45° FOV.
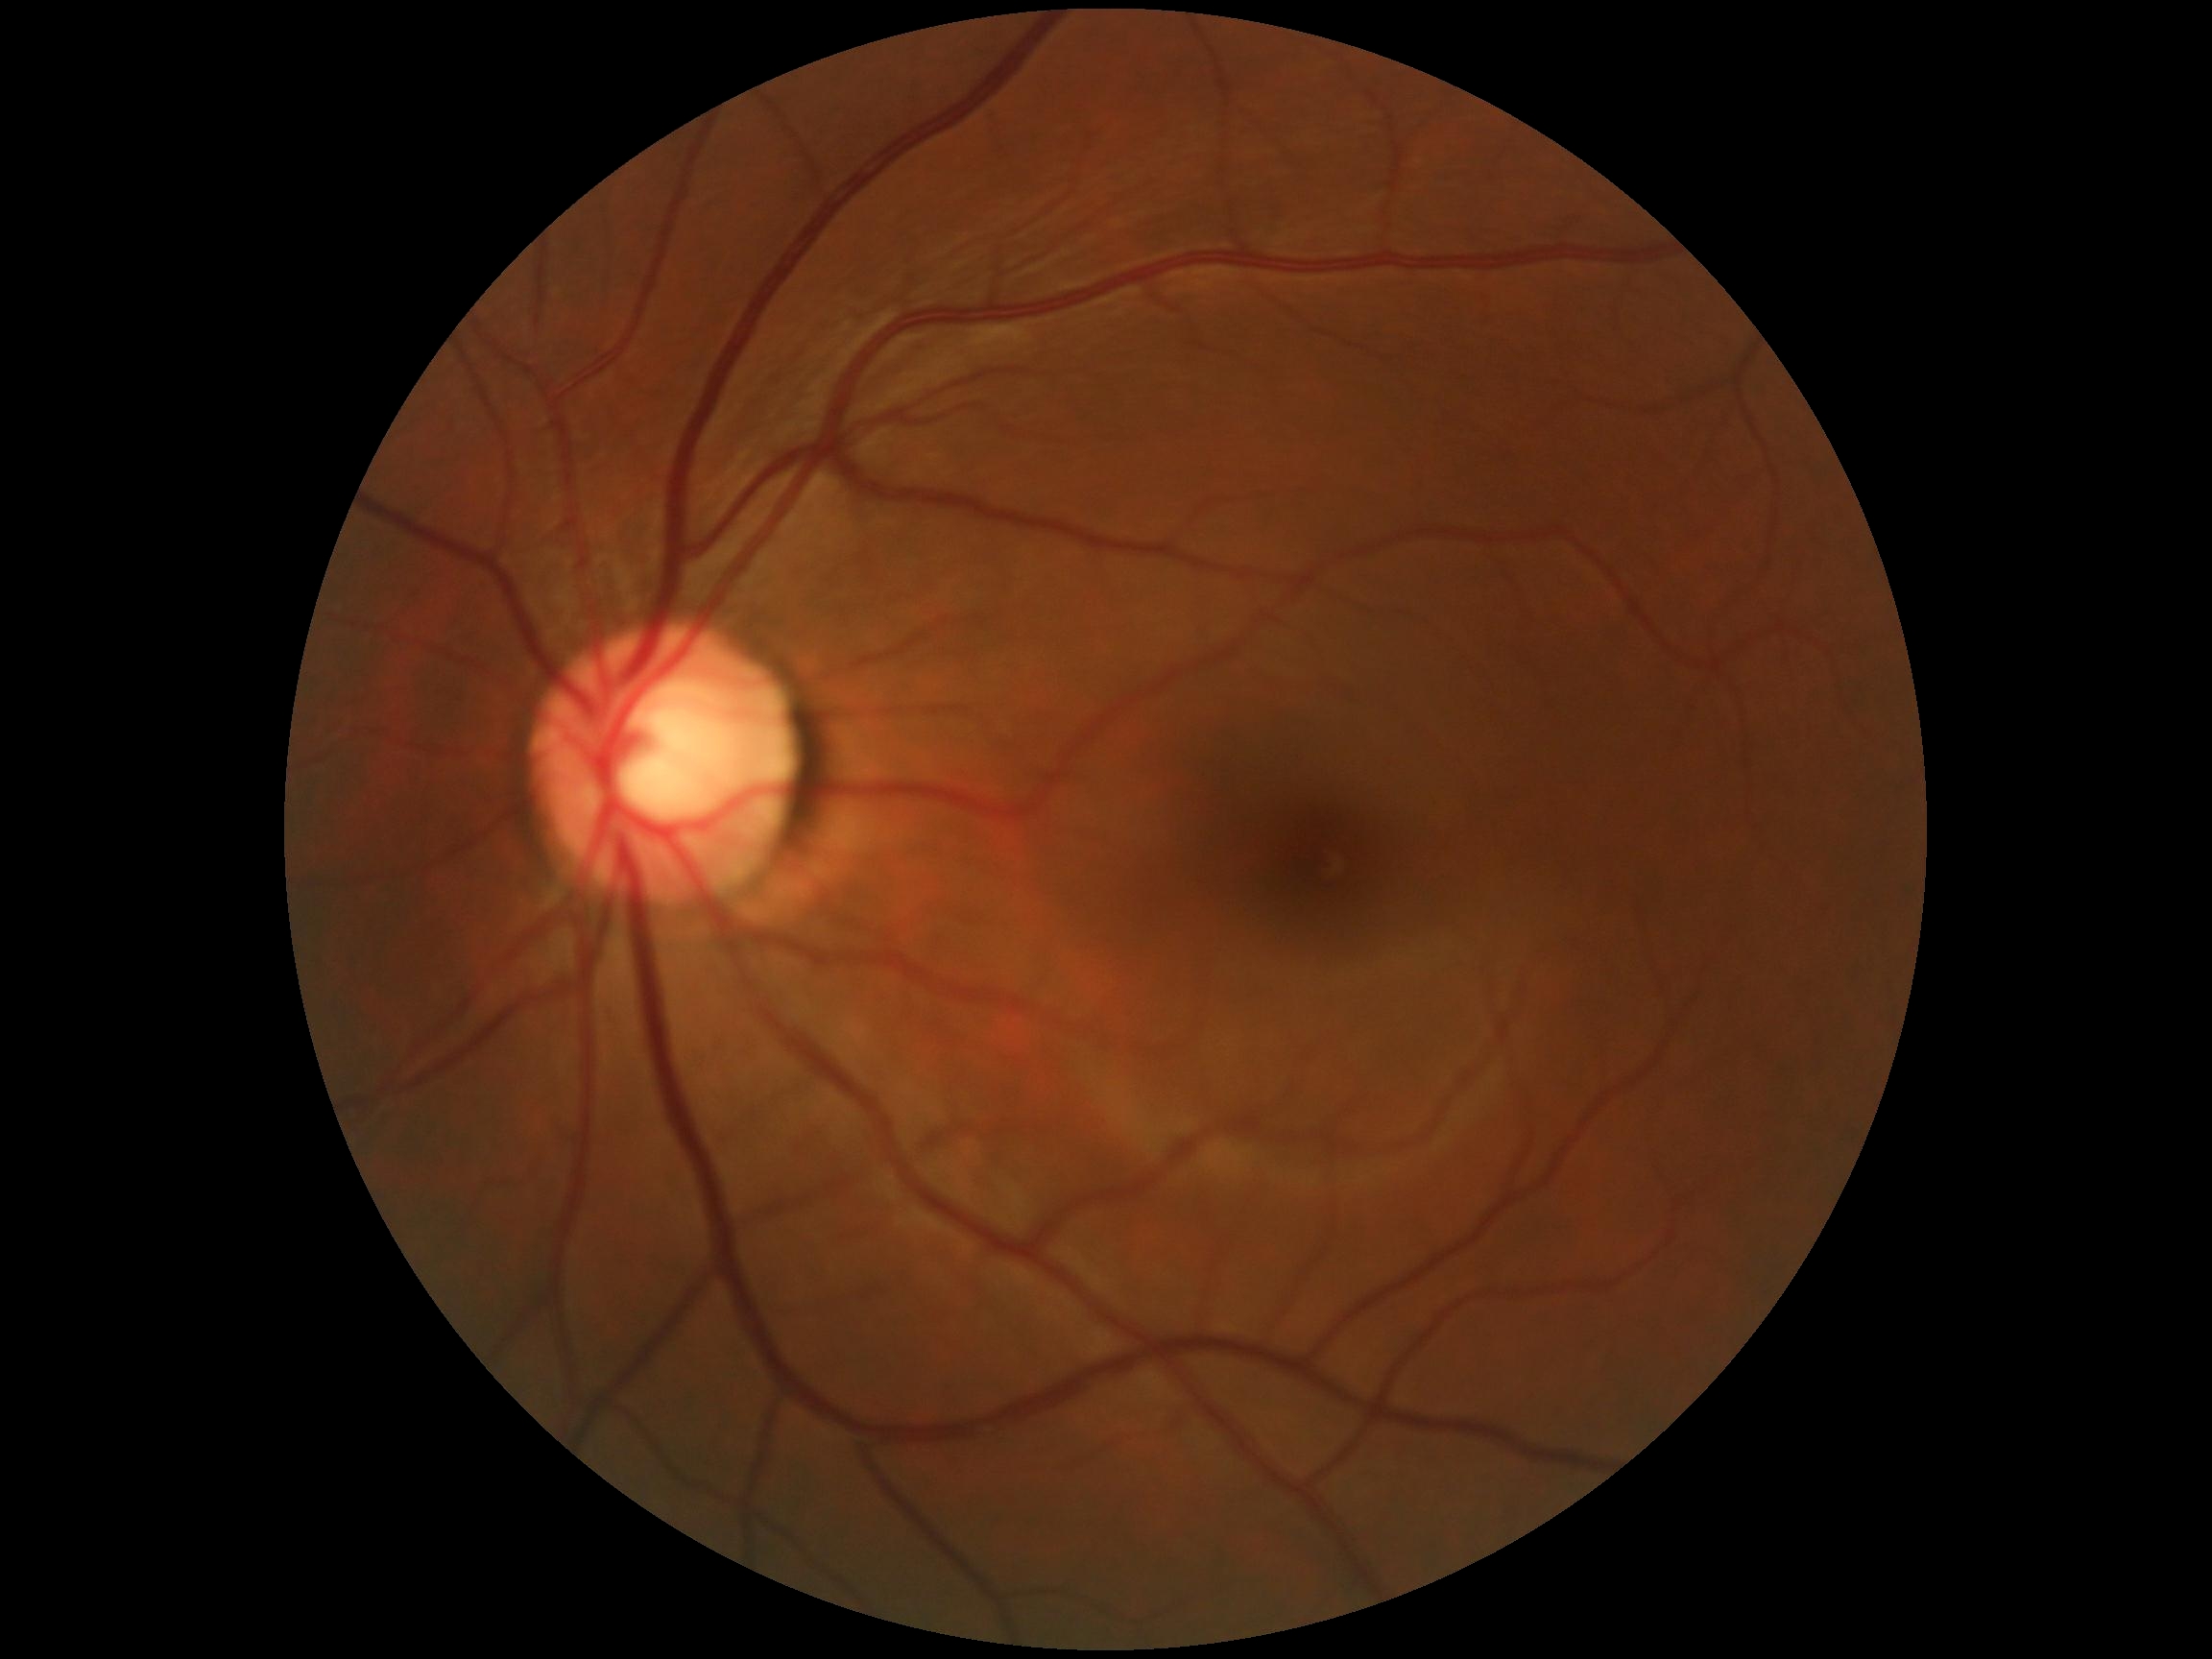

diabetic retinopathy (DR)=0.